Modified Davis classification — 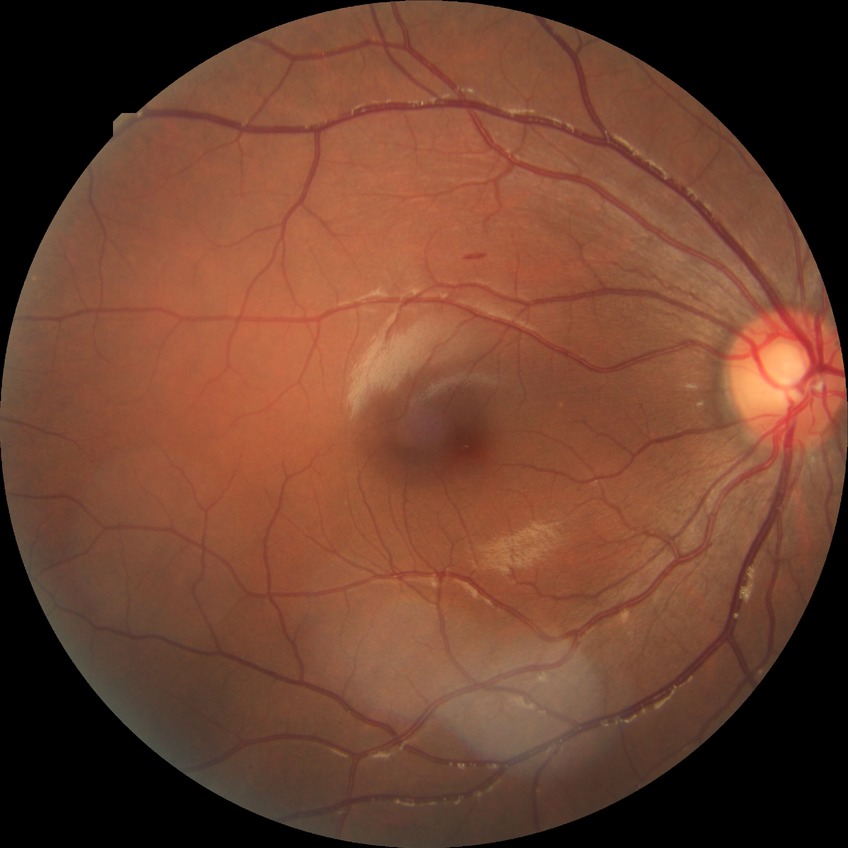

Davis grading: no diabetic retinopathy.